Graded on the modified Davis scale — 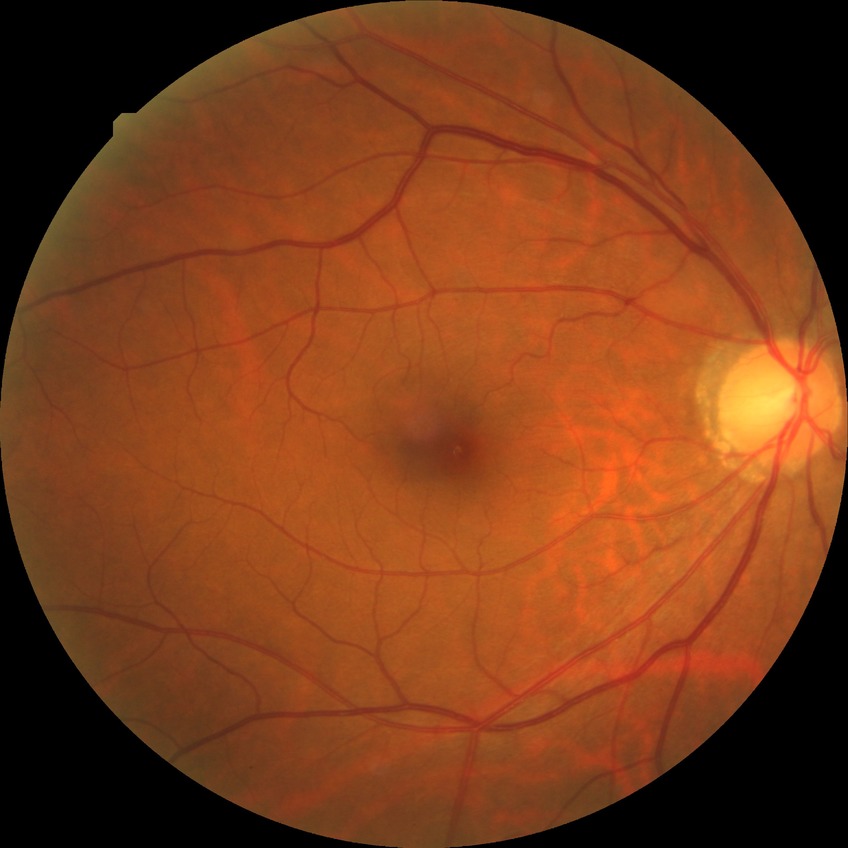 {
  "davis_grade": "NDR (no diabetic retinopathy)"
}